Optic nerve head photograph. Captured with pupil dilation — 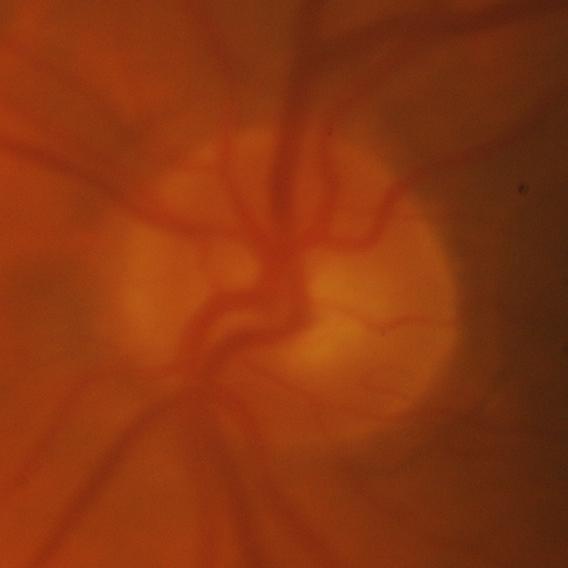

Glaucomatous changes are present. Consistent with glaucoma.